45-degree field of view — 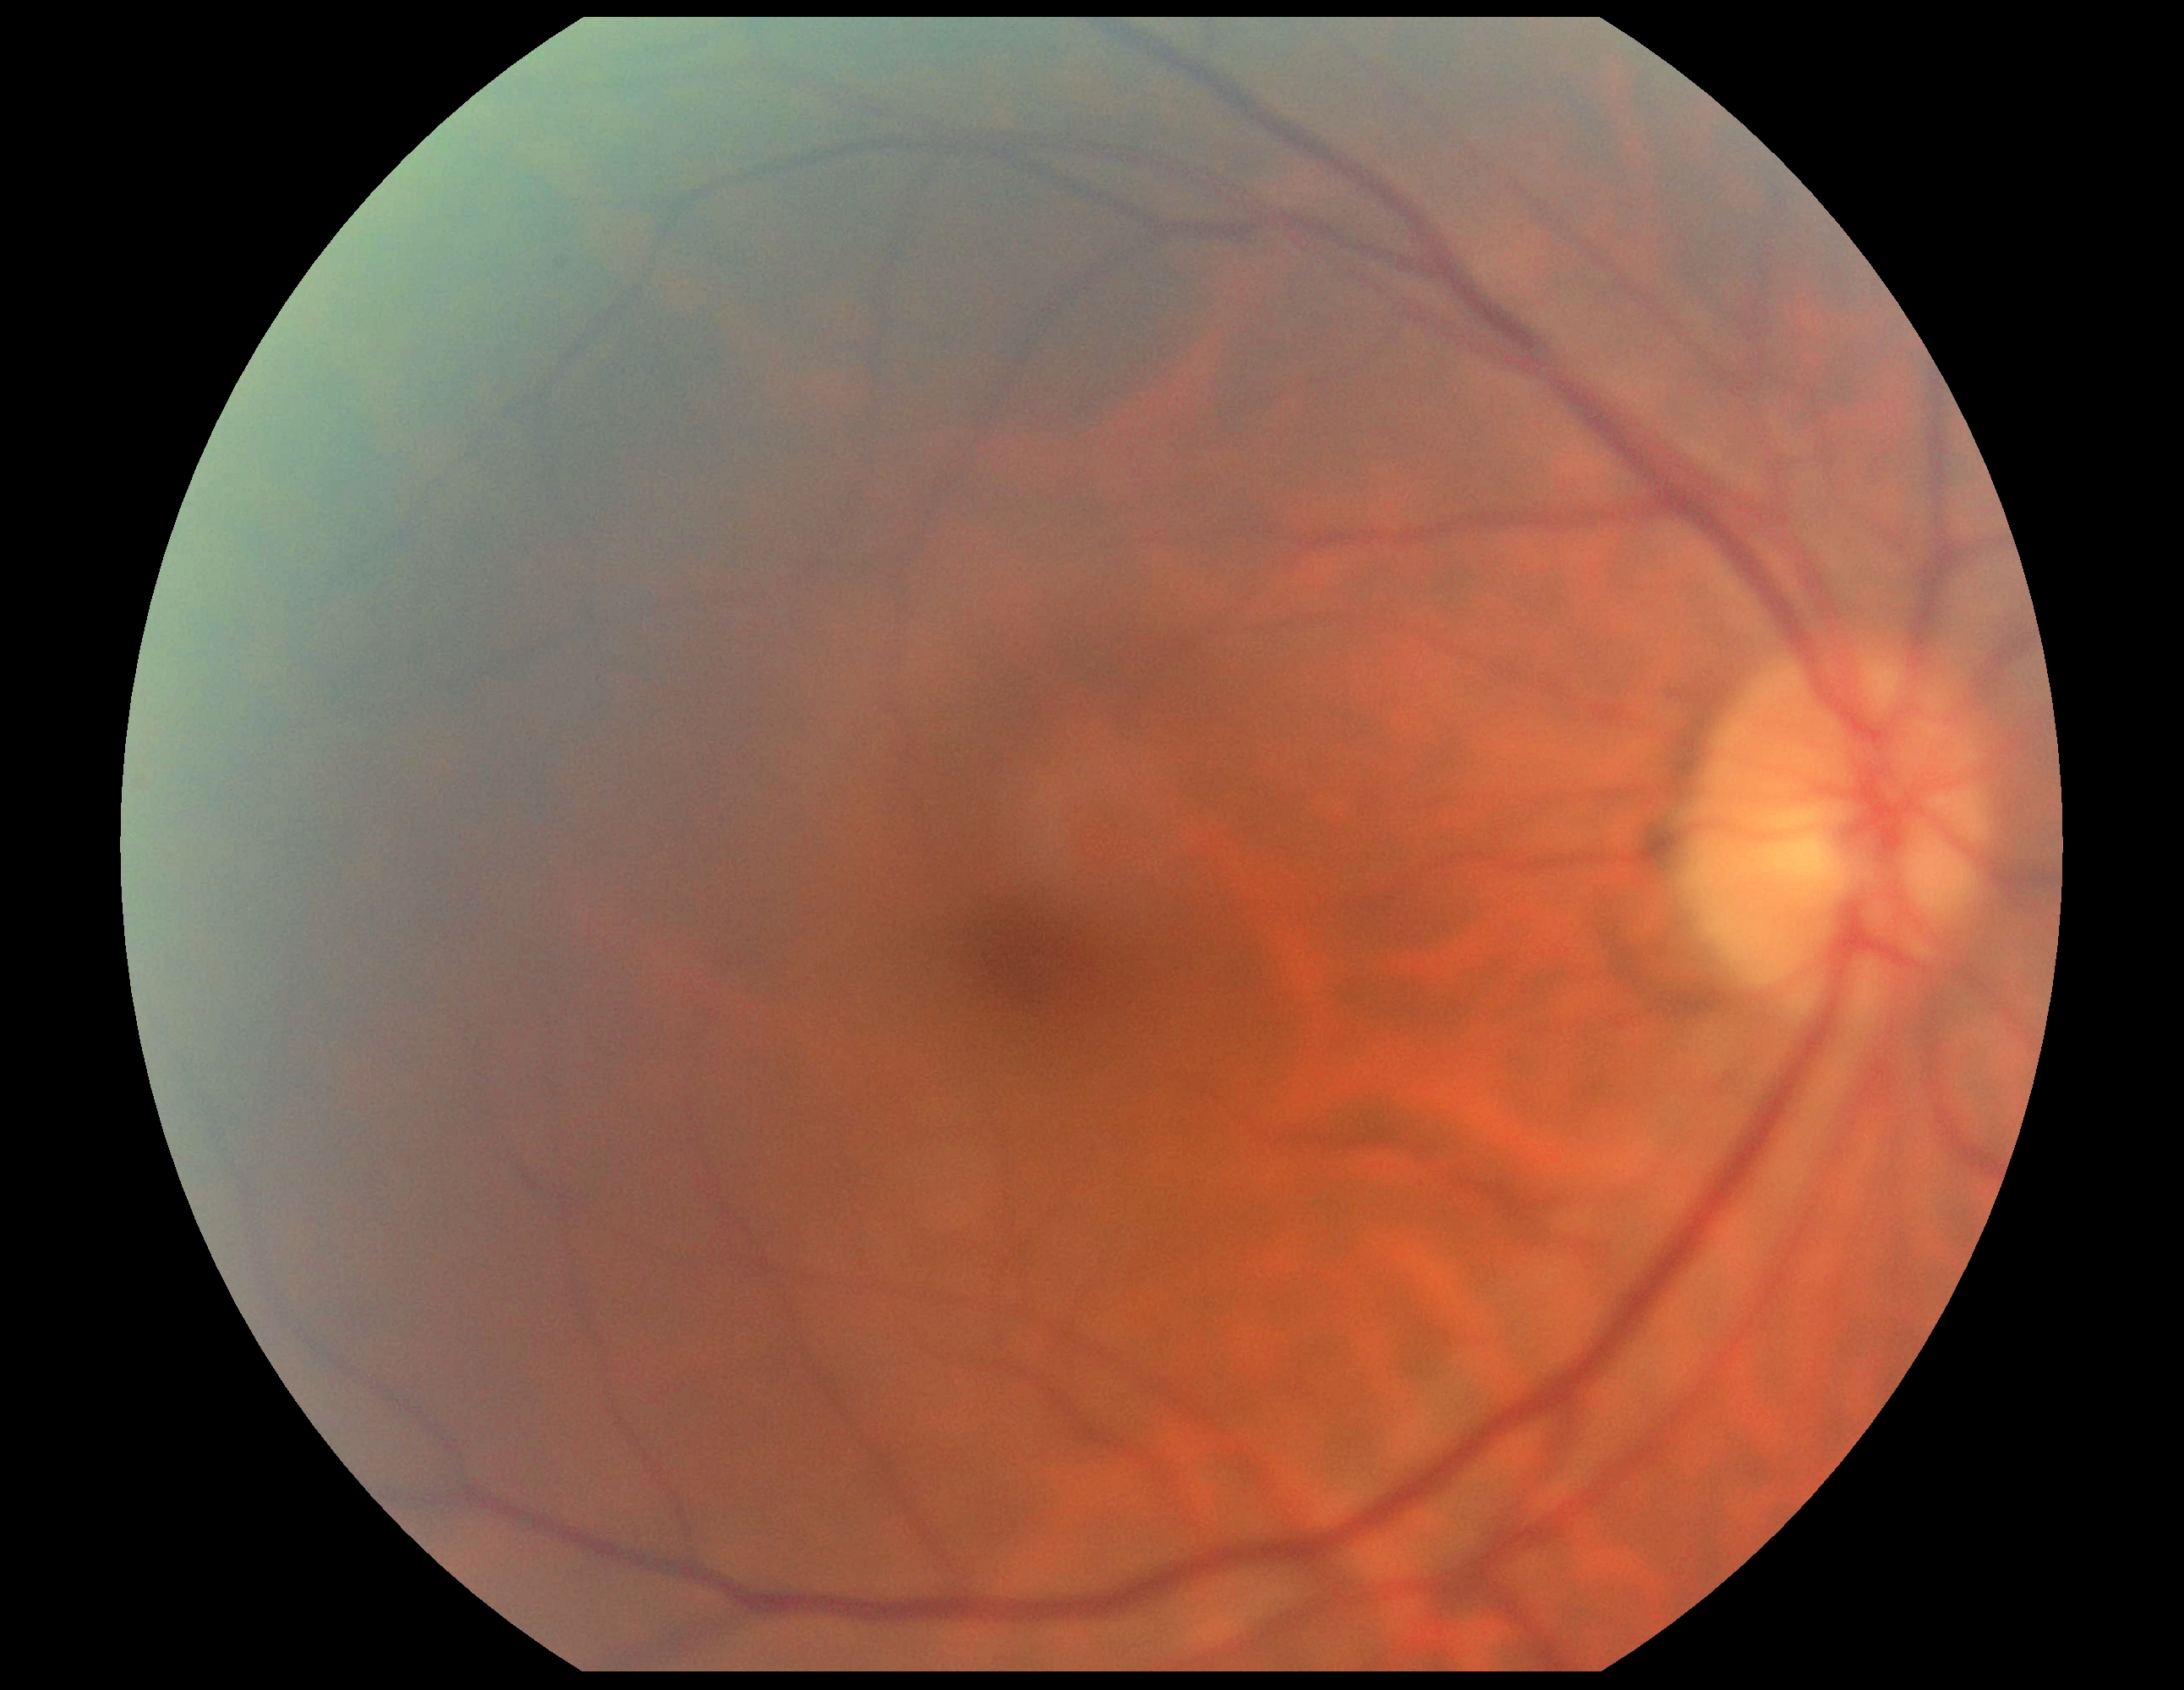 No apparent diabetic retinopathy. Retinopathy is 0.